Diabetic retinopathy graded by the modified Davis classification: 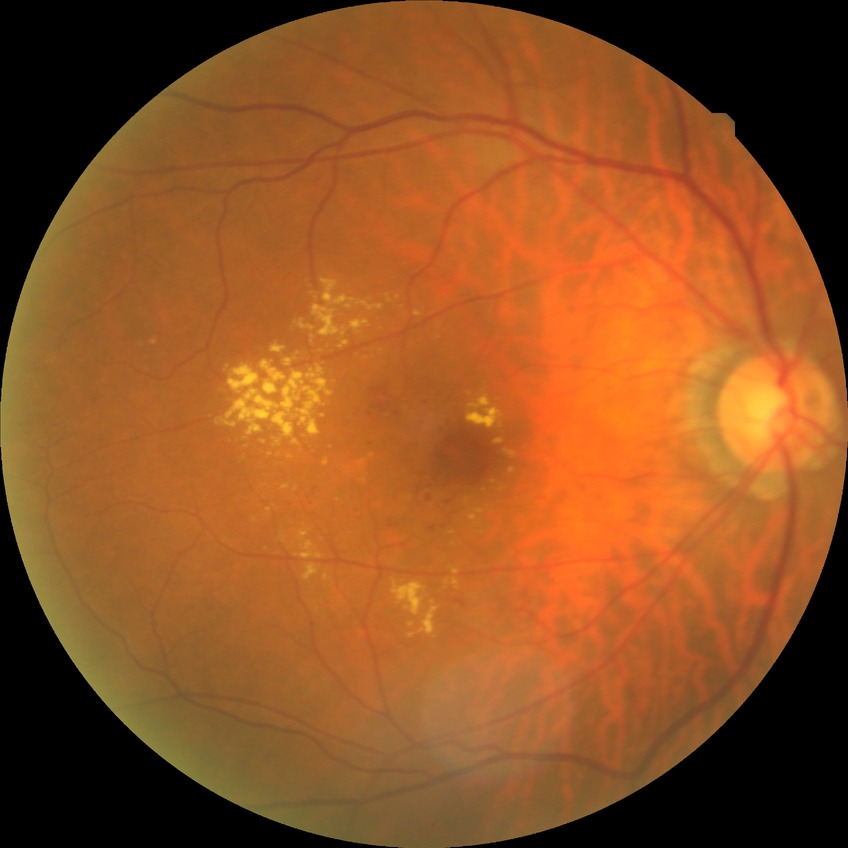 Davis grade: NDR.